1659 by 2212 pixels. Camera: Remidio Fundus on Phone.
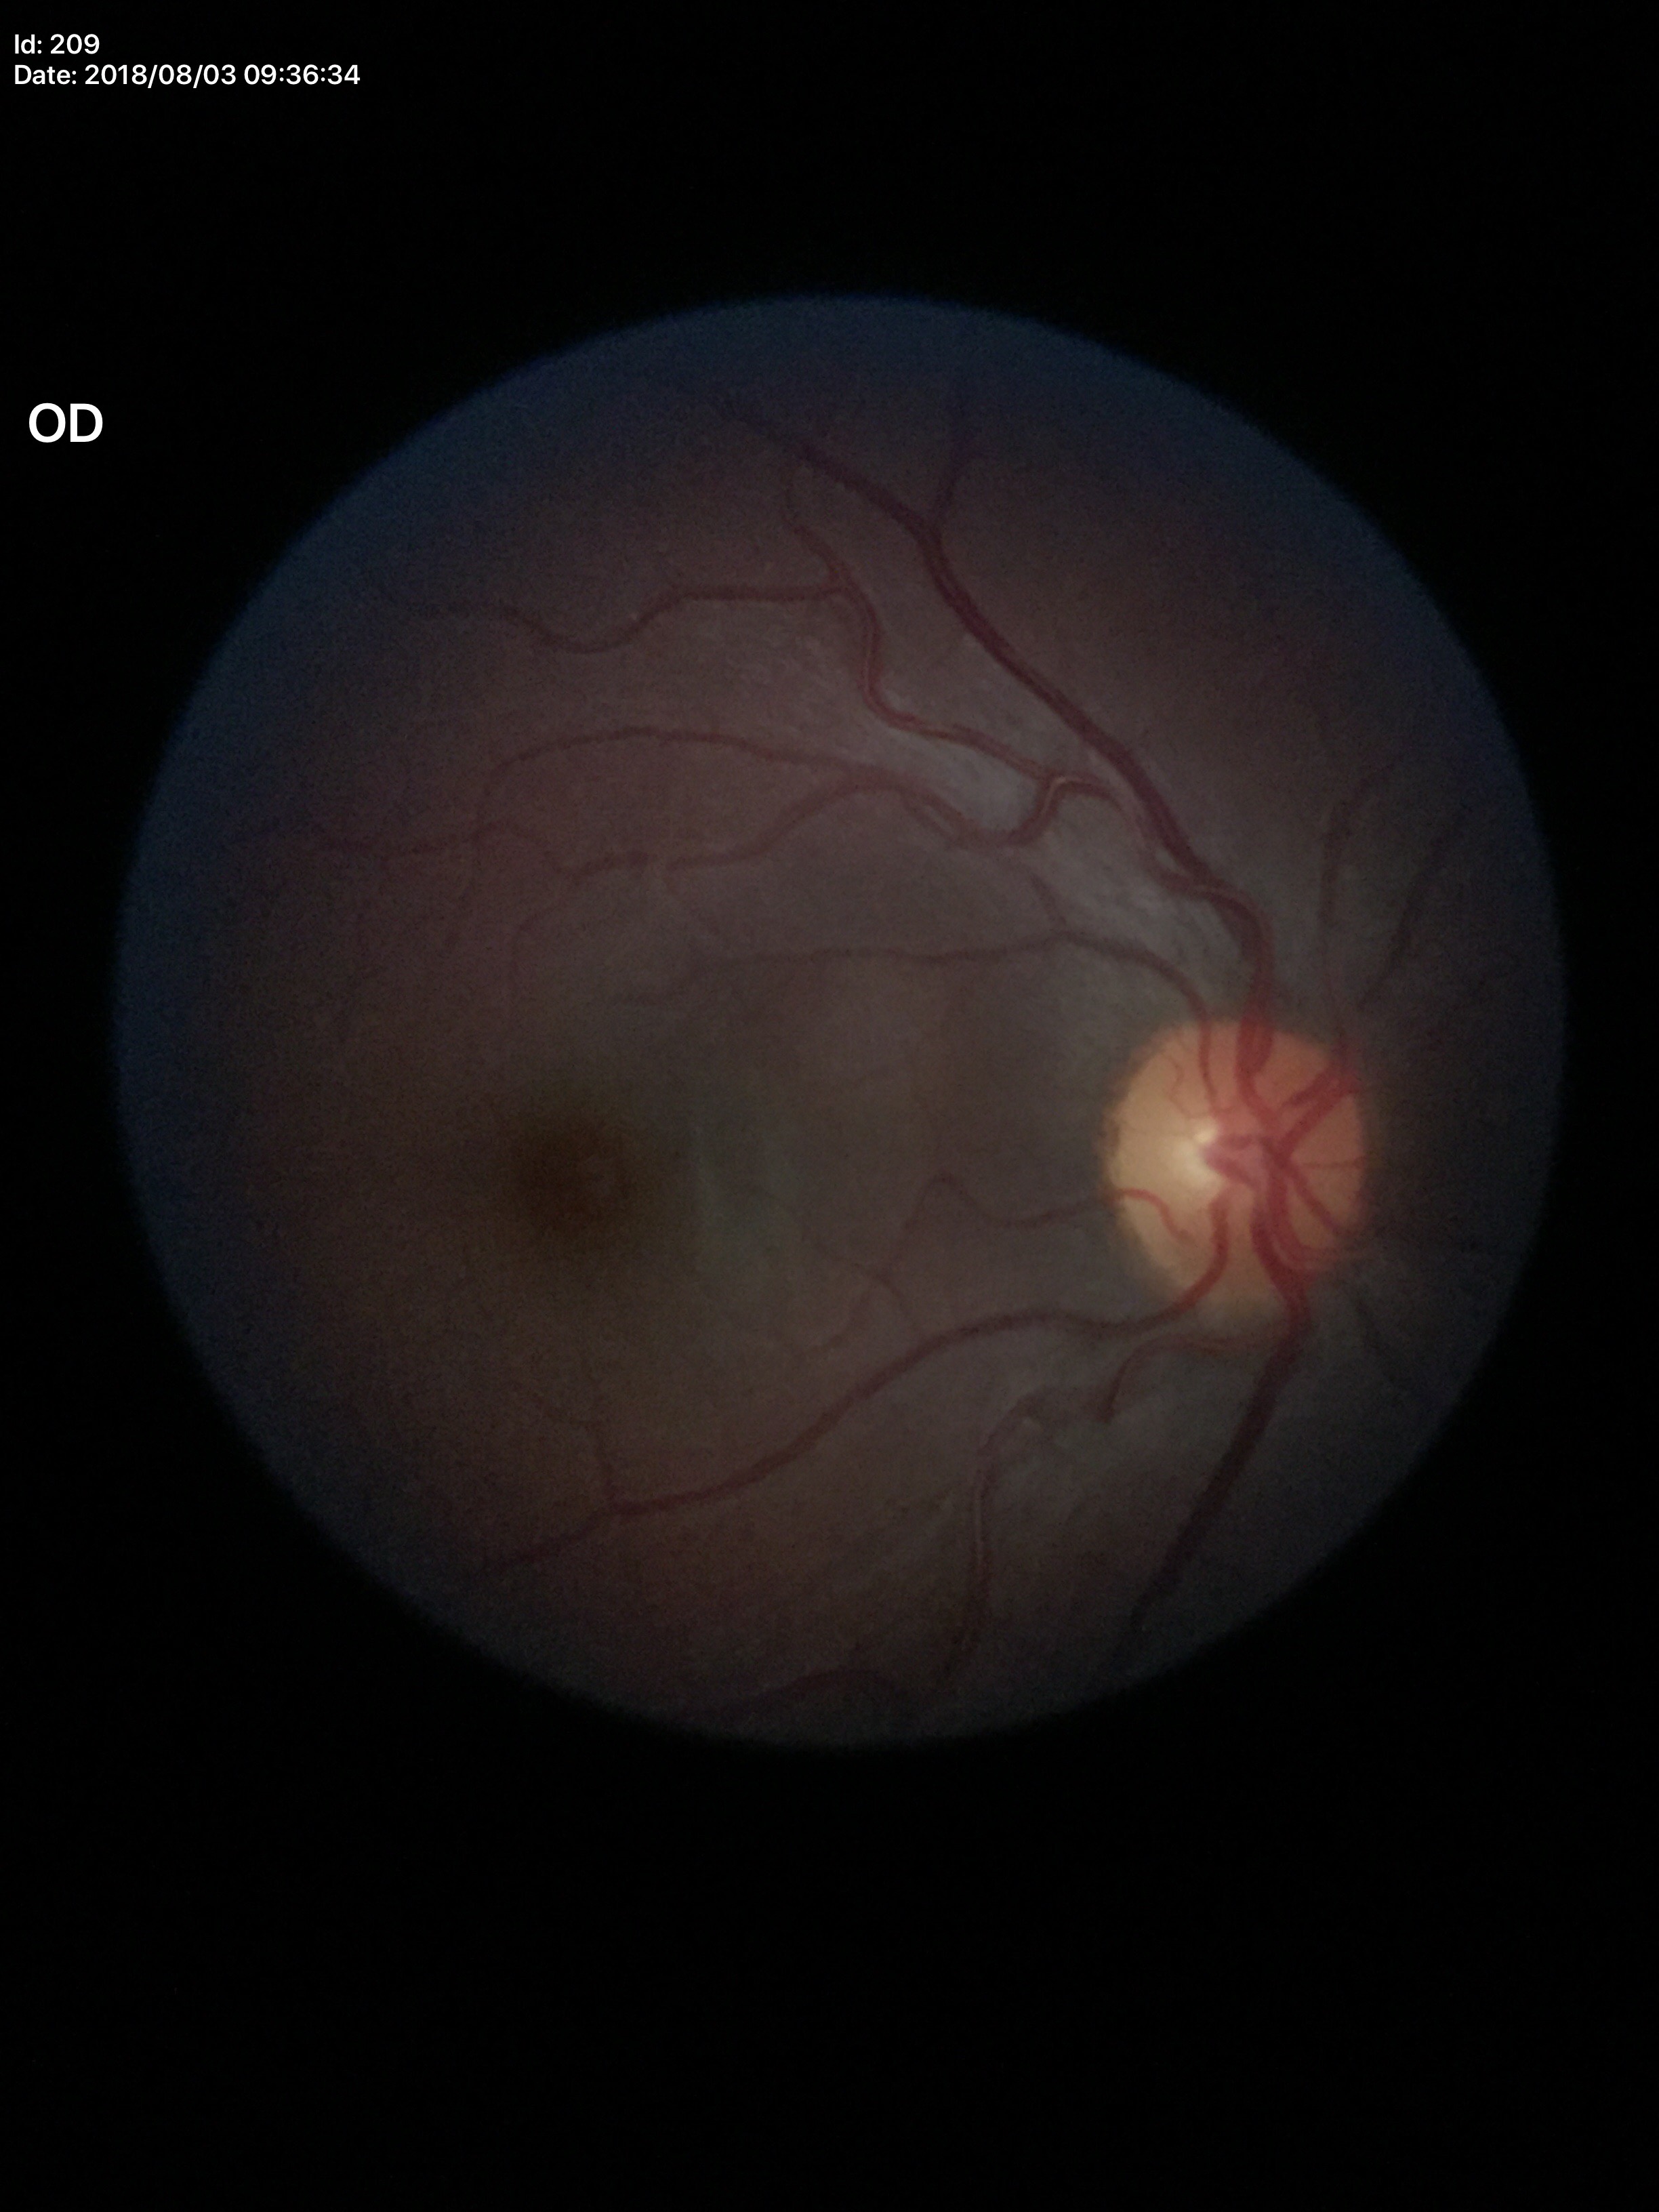
Glaucoma evaluation=not suspect; vertical CDR=0.32; horizontal cup-disc ratio=0.41; area CDR=0.13